45 degree fundus photograph; acquired with a NIDEK AFC-230; posterior pole photograph; without pupil dilation — 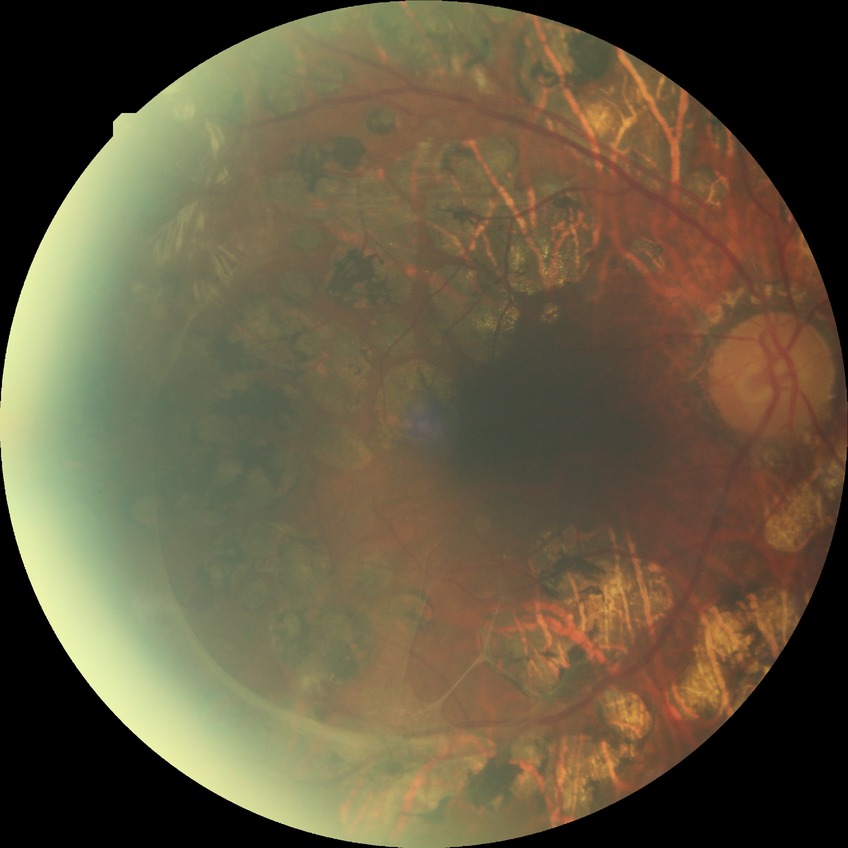

{"davis_grade": "proliferative diabetic retinopathy (PDR)"}